Image size 1440x1080 · camera: Natus RetCam Envision (130° FOV) · infant wide-field retinal image
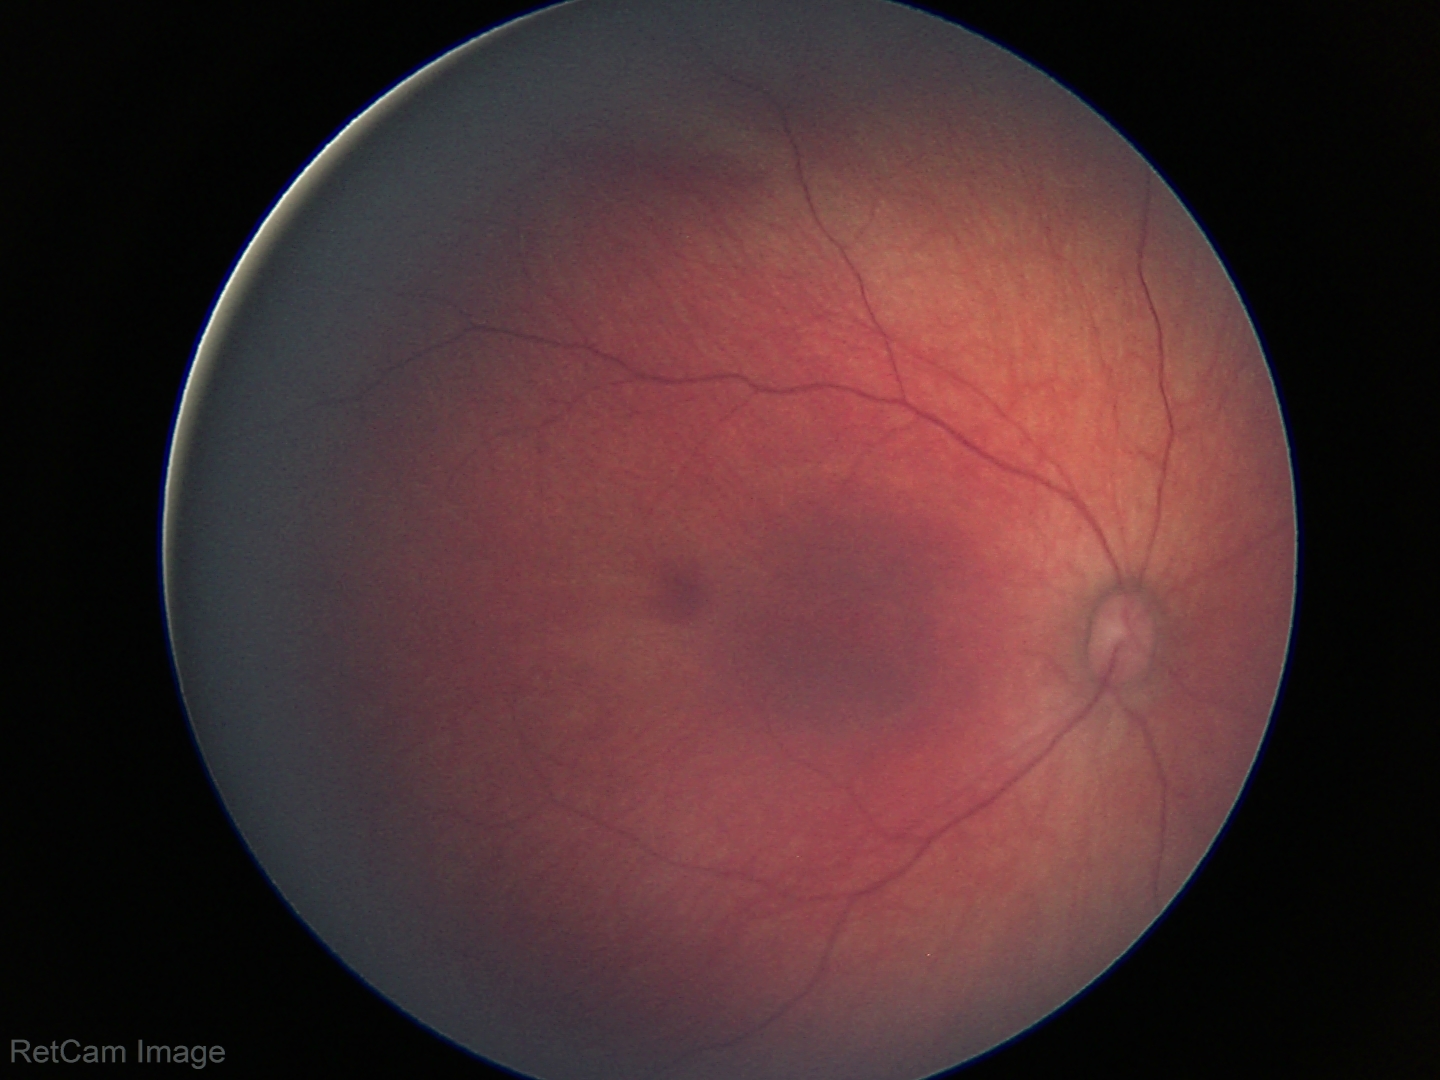 Physiological retinal appearance for postconceptual age.